UWF retinal mosaic.
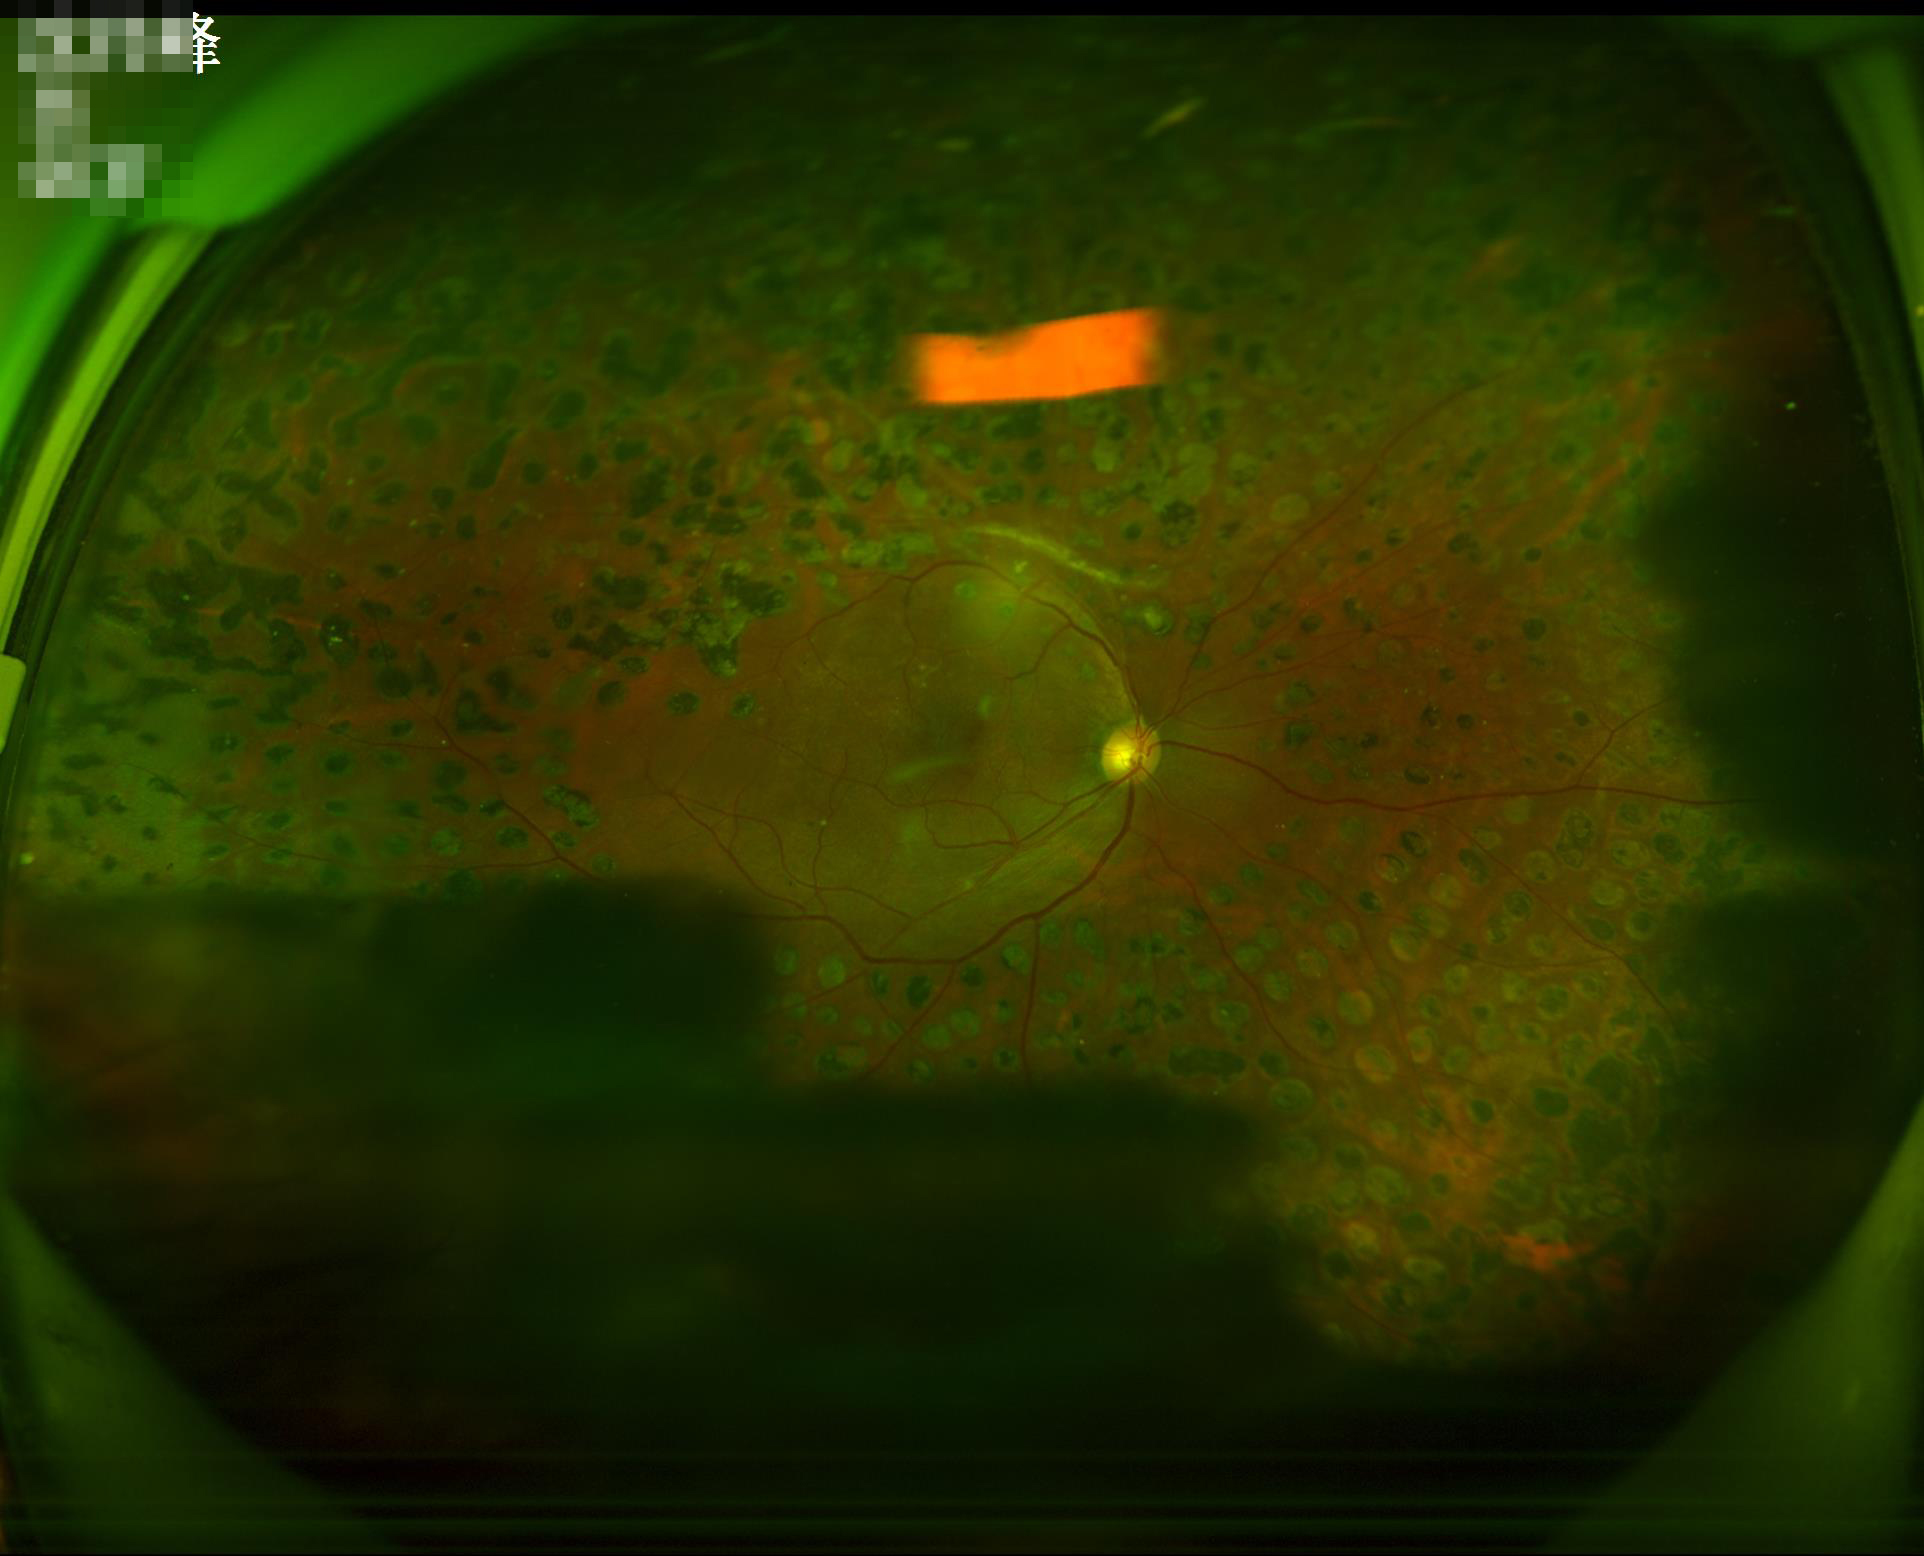

{
  "overall_quality": "low",
  "contrast": "satisfactory",
  "clarity": "good",
  "illumination": "poor"
}